2352x1568. 45° FOV. Color fundus photograph — 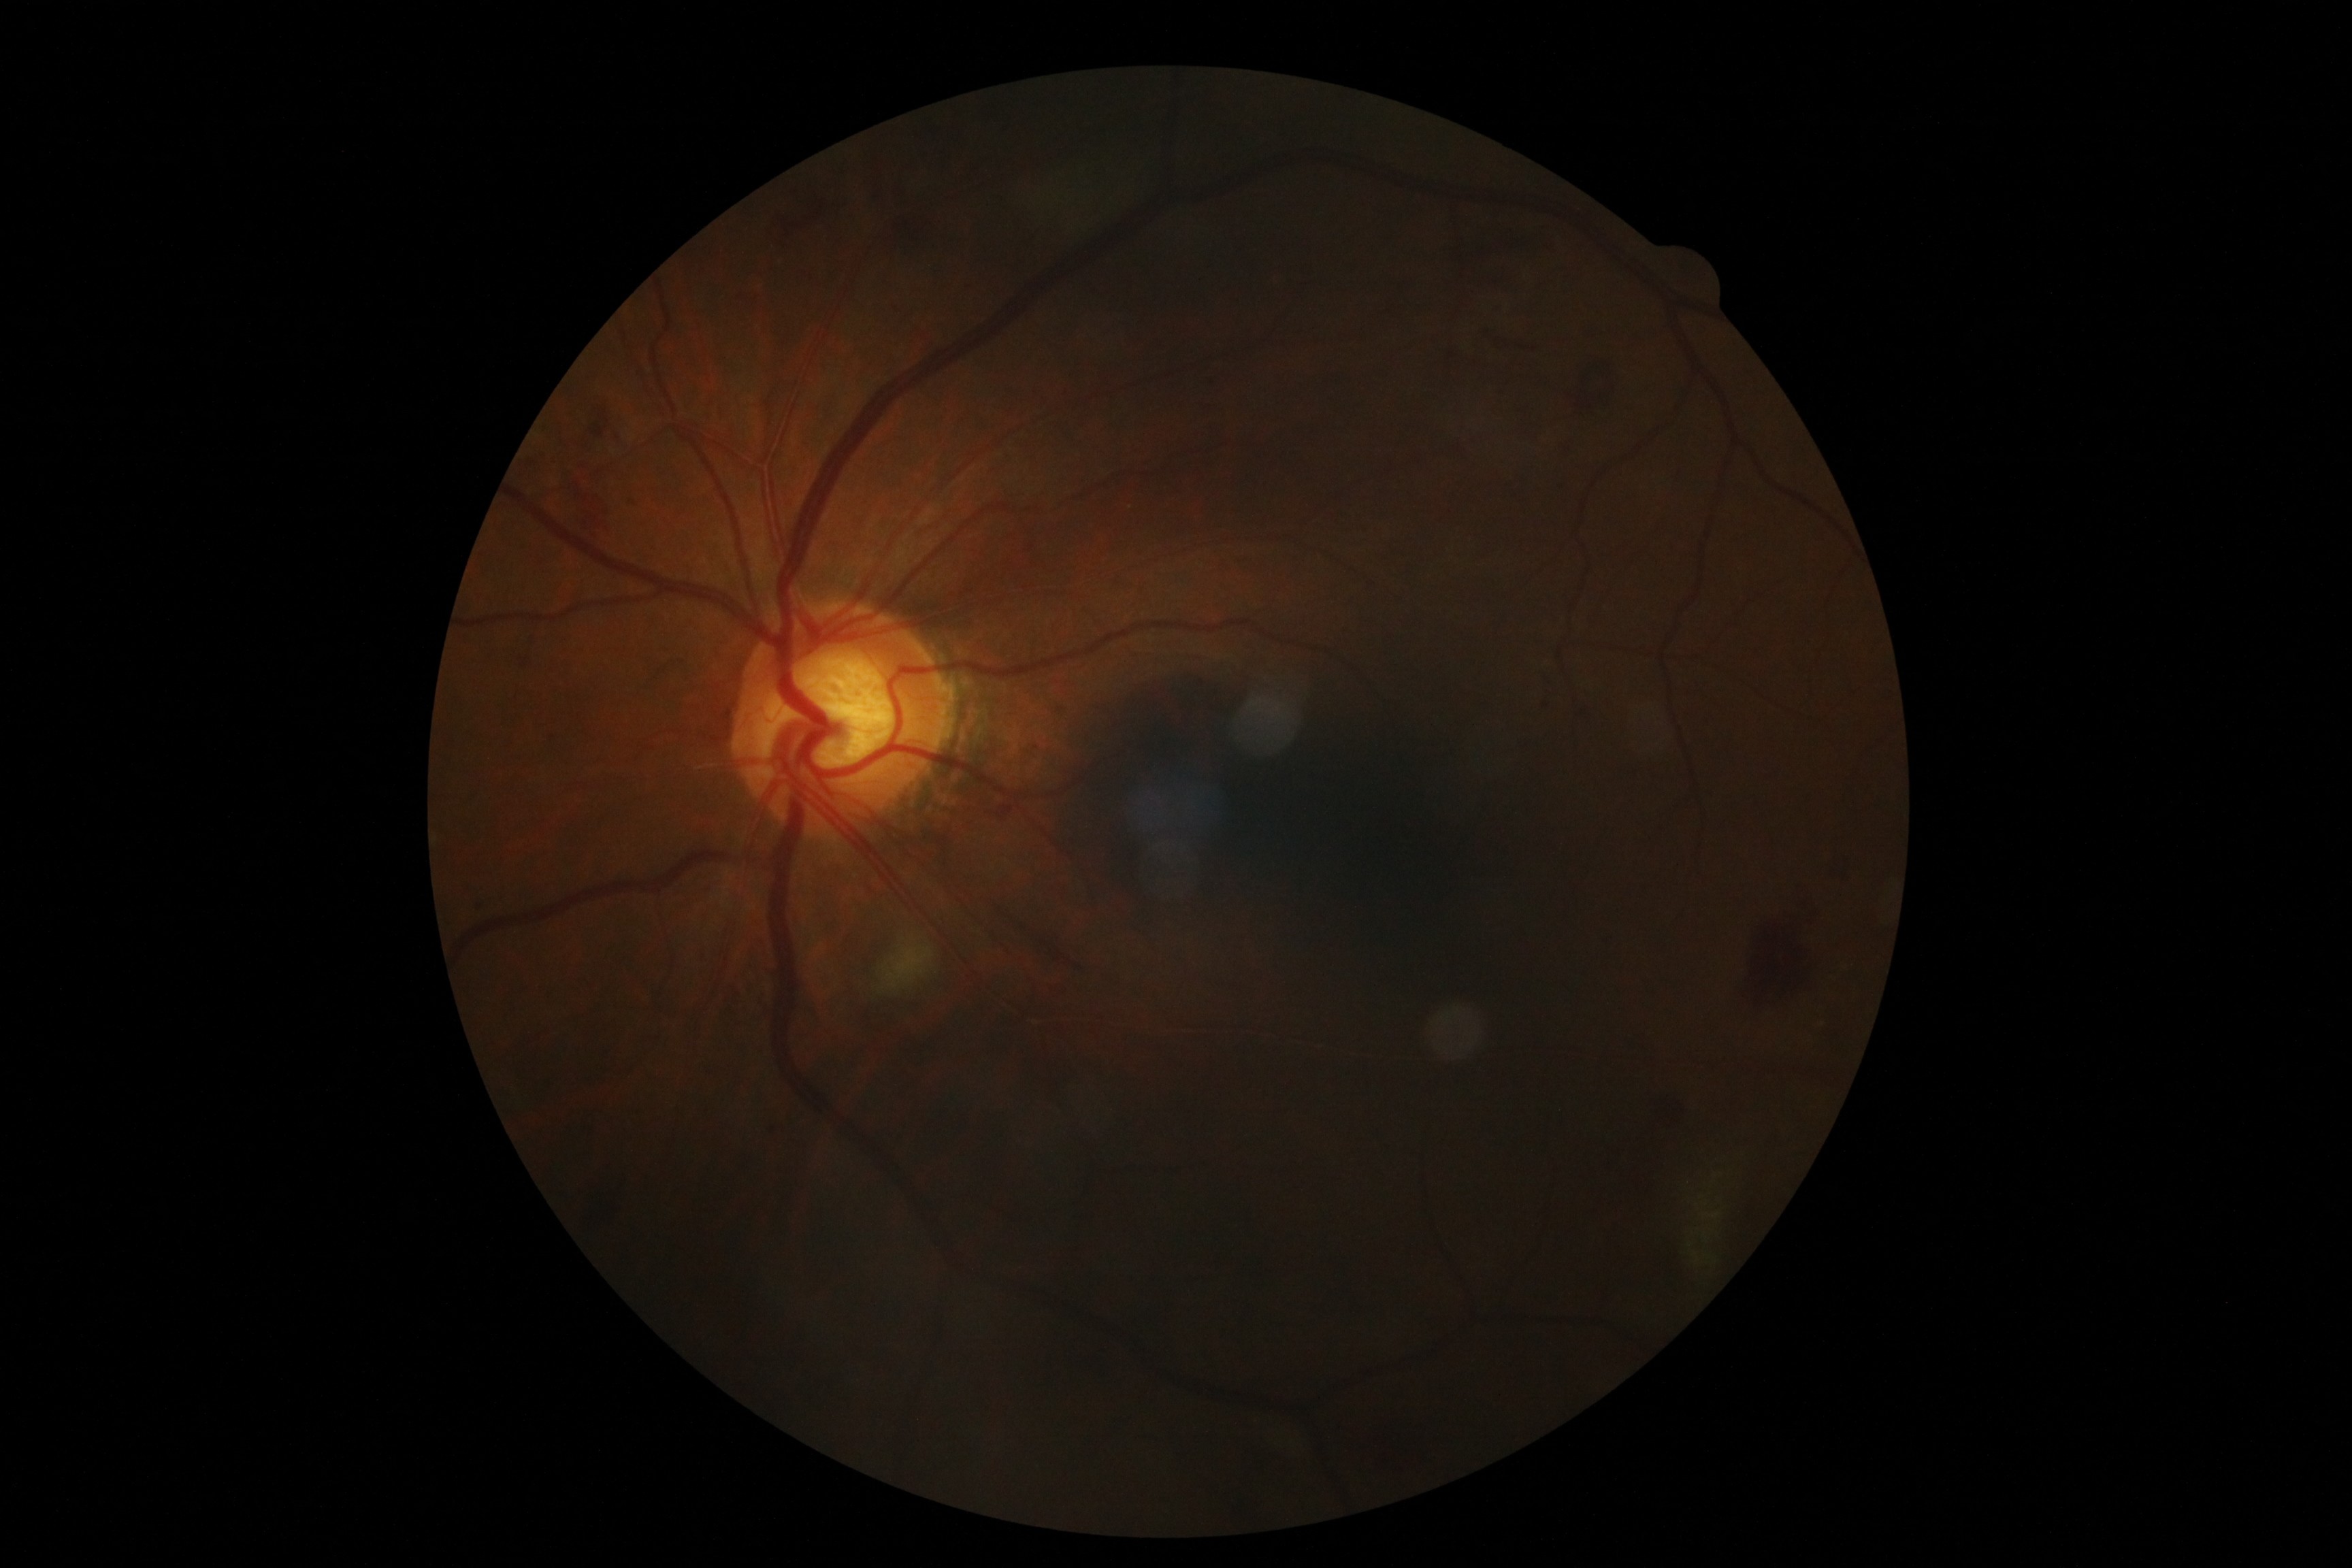
Diabetic retinopathy grade is moderate NPDR (2).